Pediatric retinal photograph (wide-field). 100° field of view (Phoenix ICON).
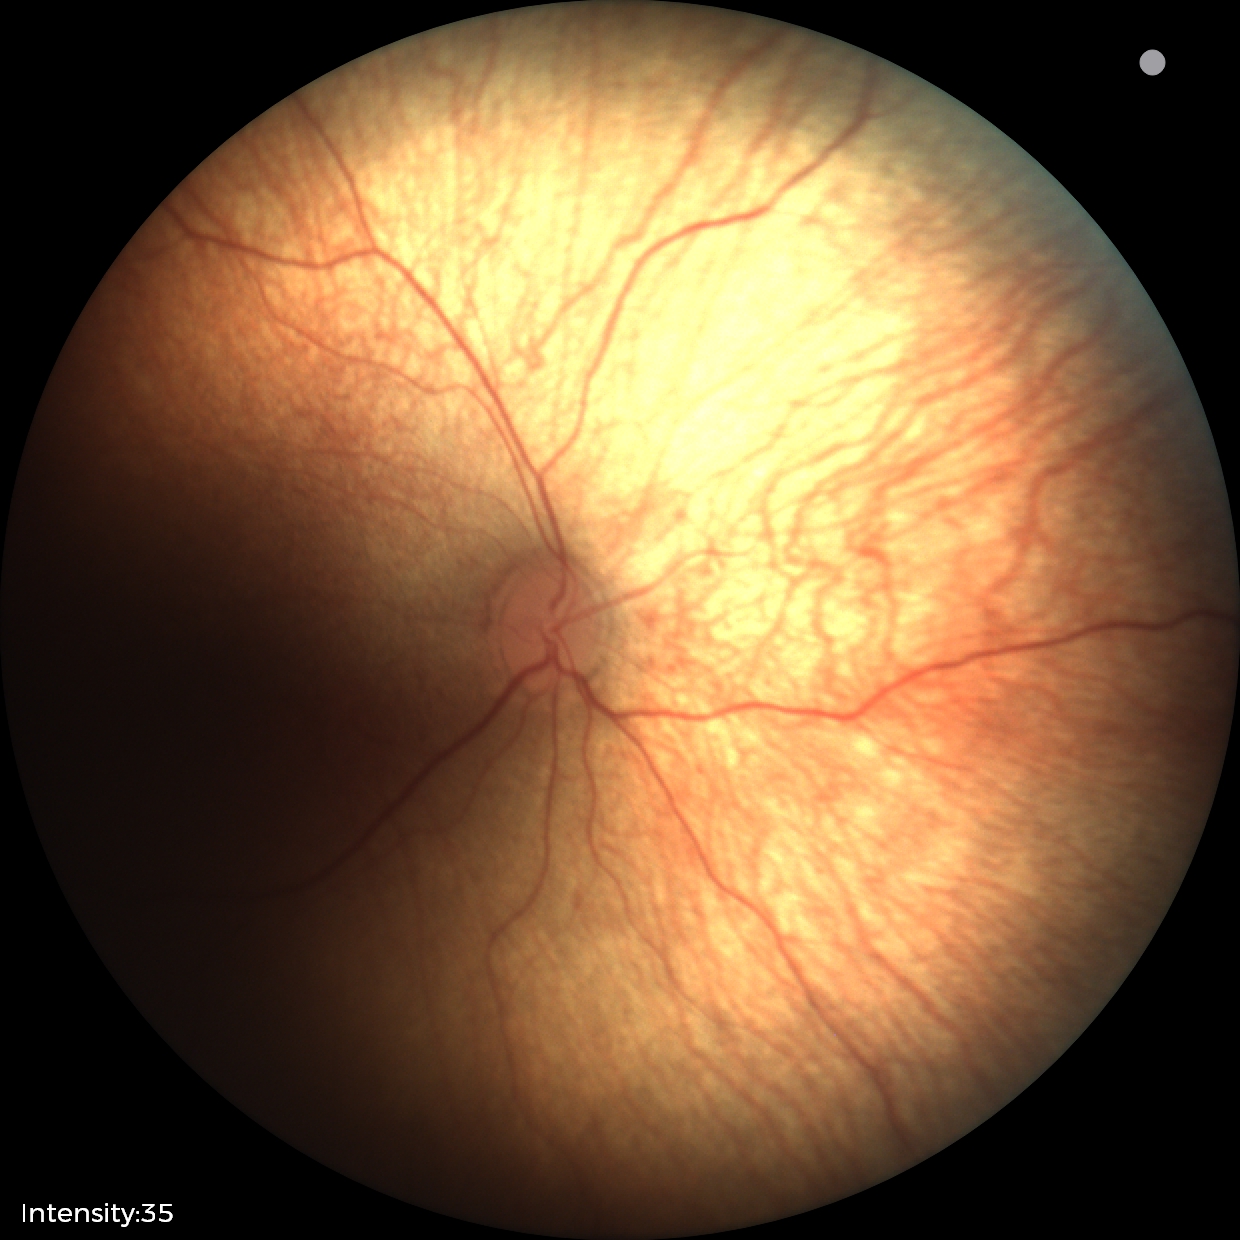

Screening: no abnormal retinal findings.